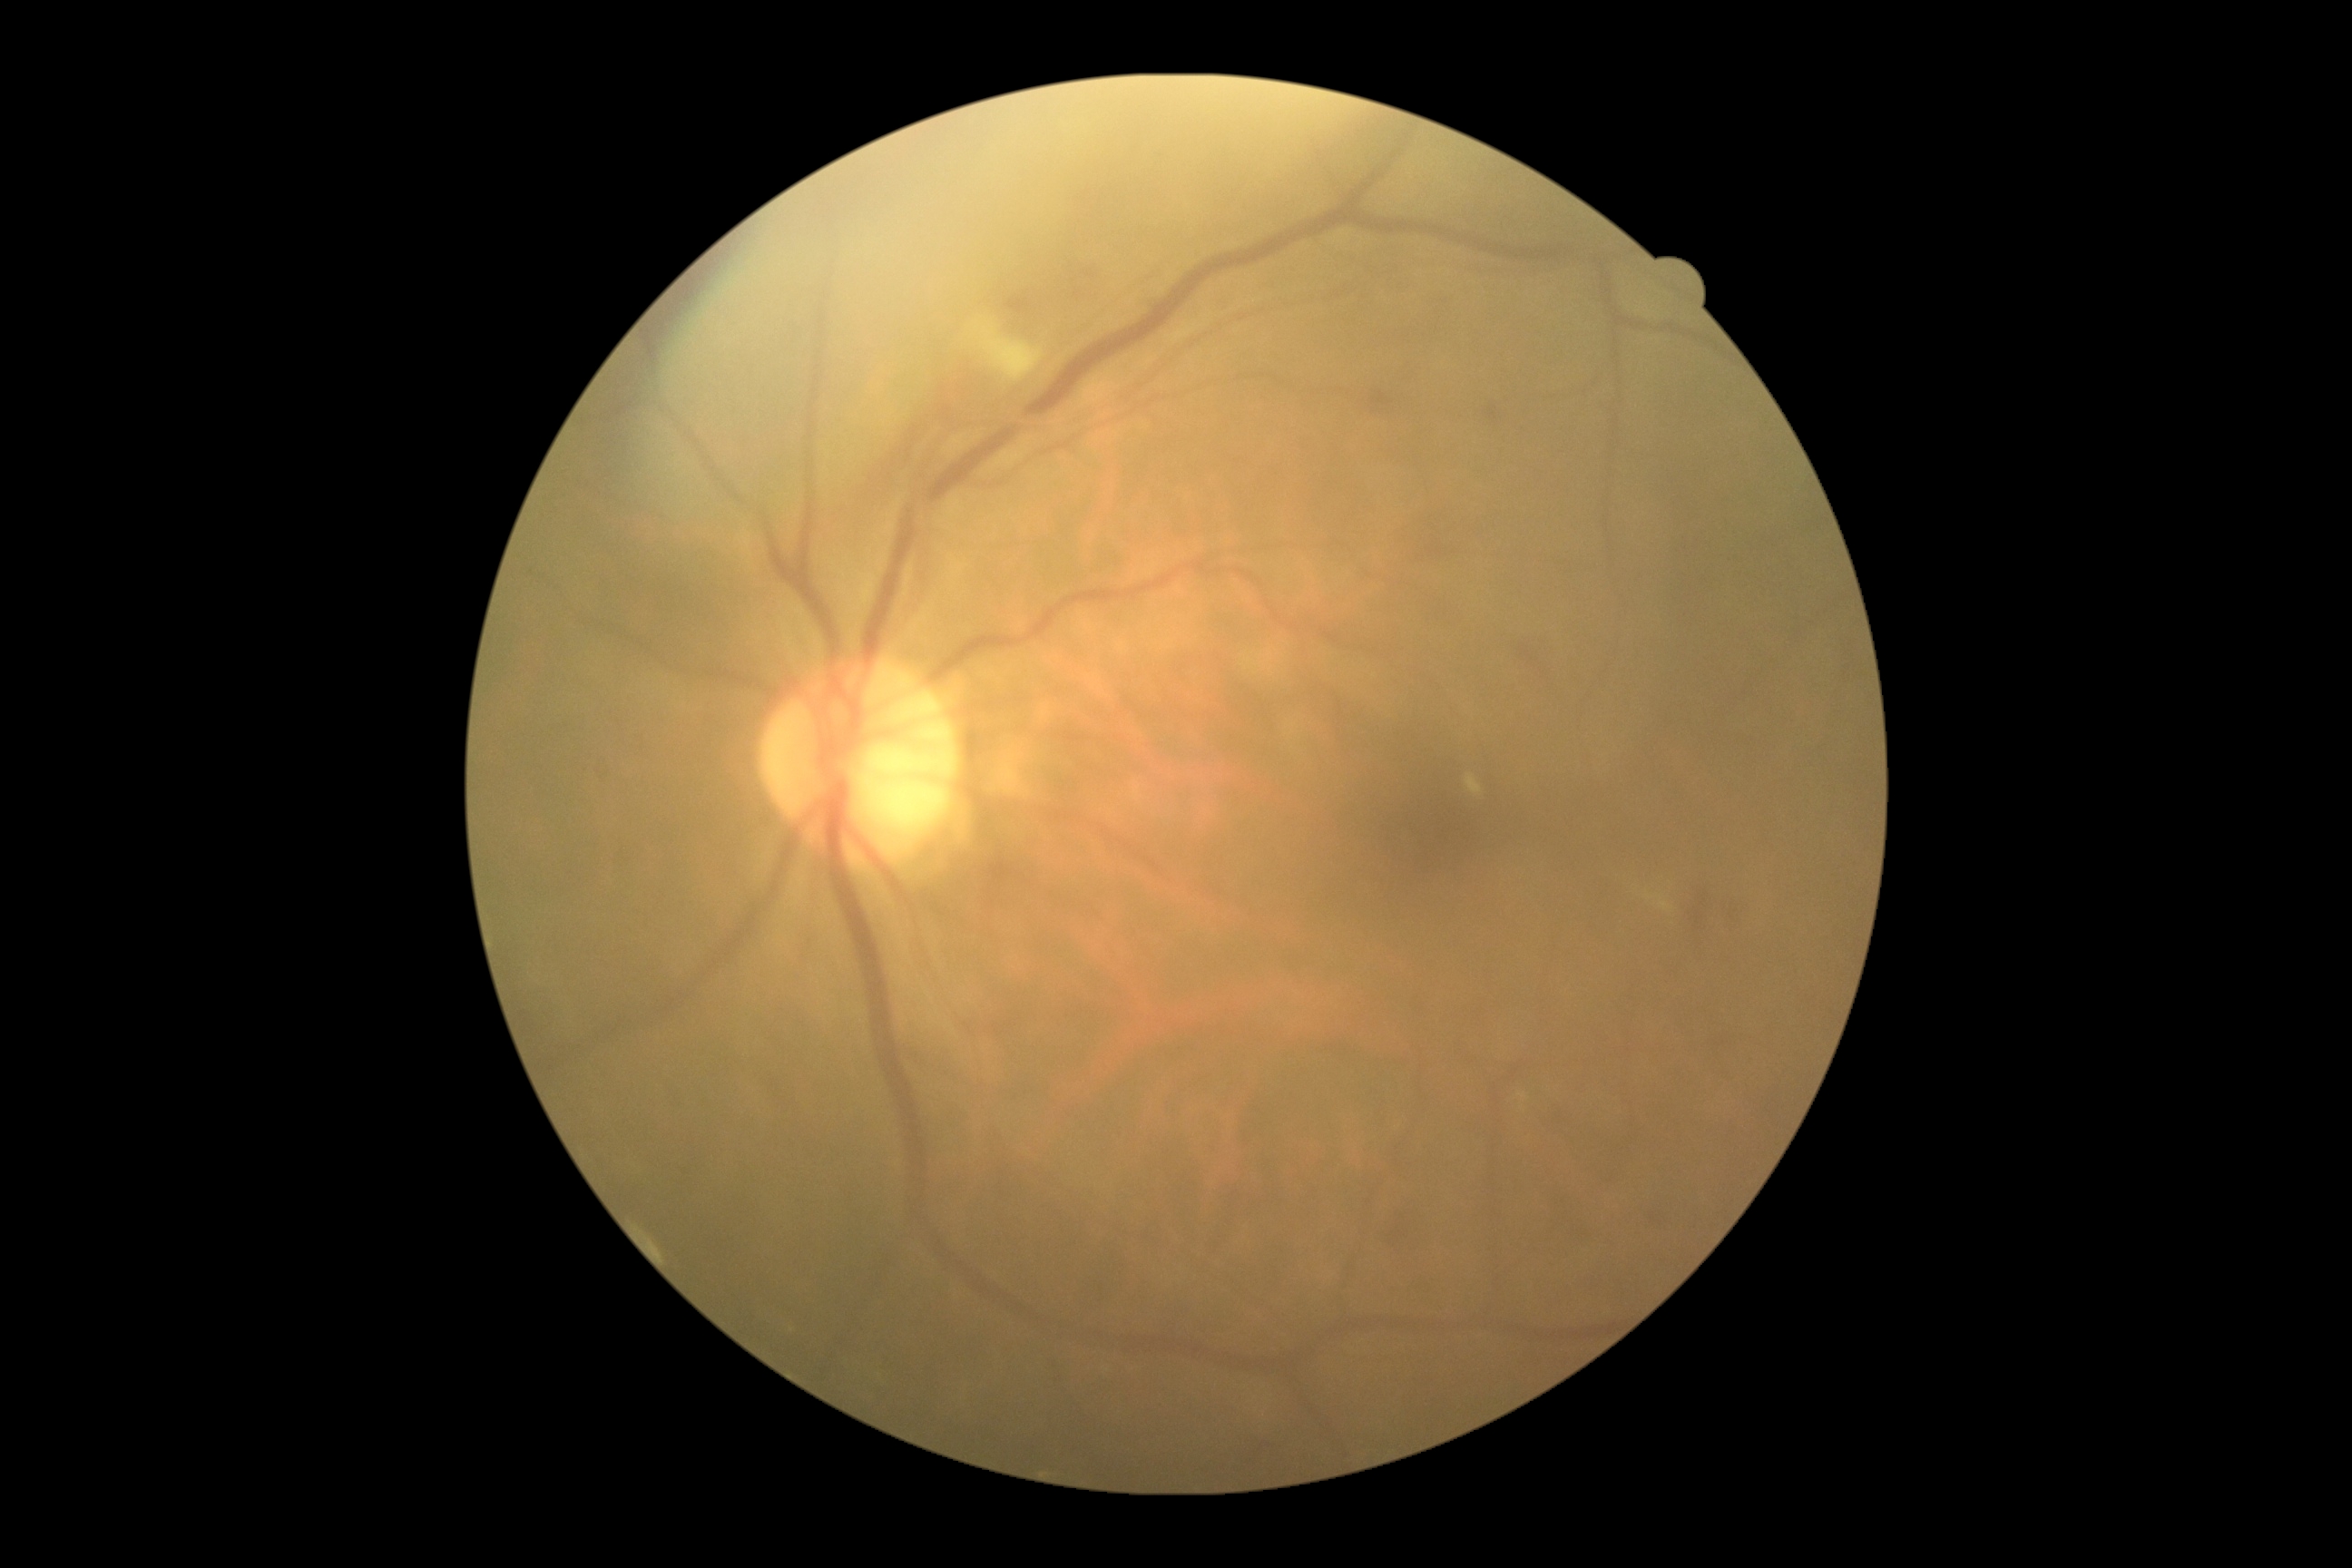 The retinopathy is classified as non-proliferative diabetic retinopathy. DR severity: 2.